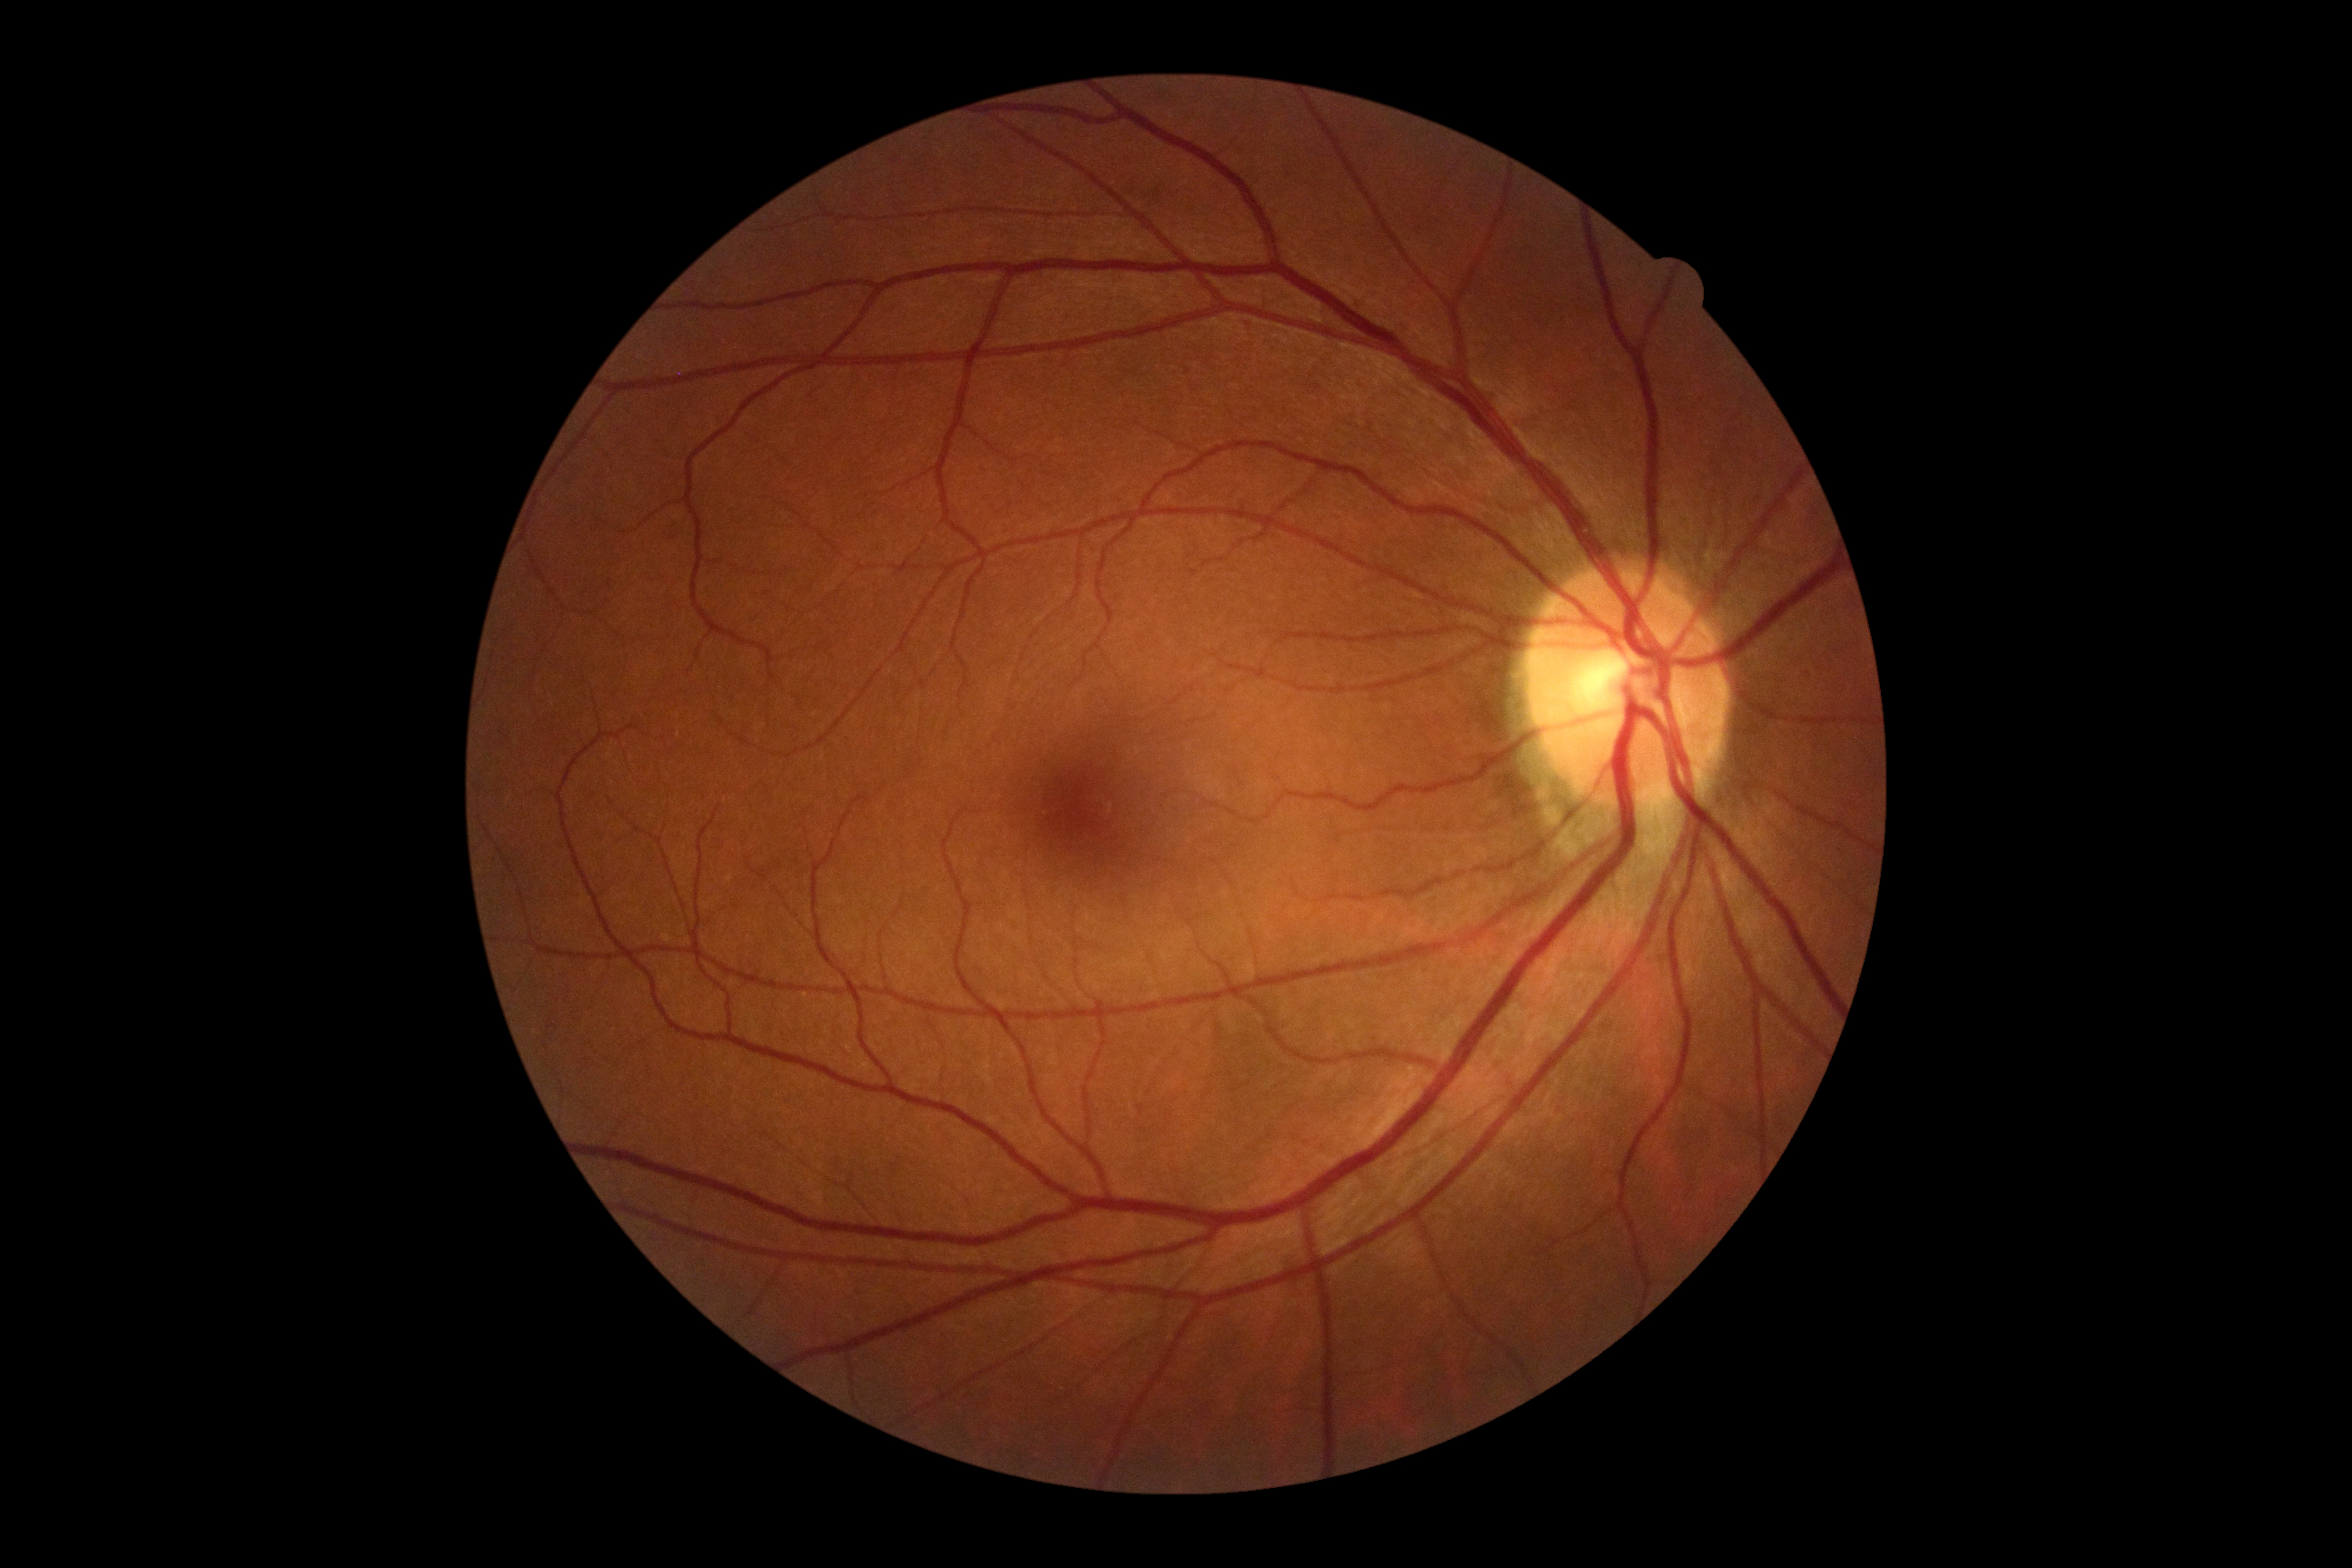 DR grade: 0 (no apparent retinopathy).